Infant wide-field retinal image; 1240x1240px; acquired on the Phoenix ICON:
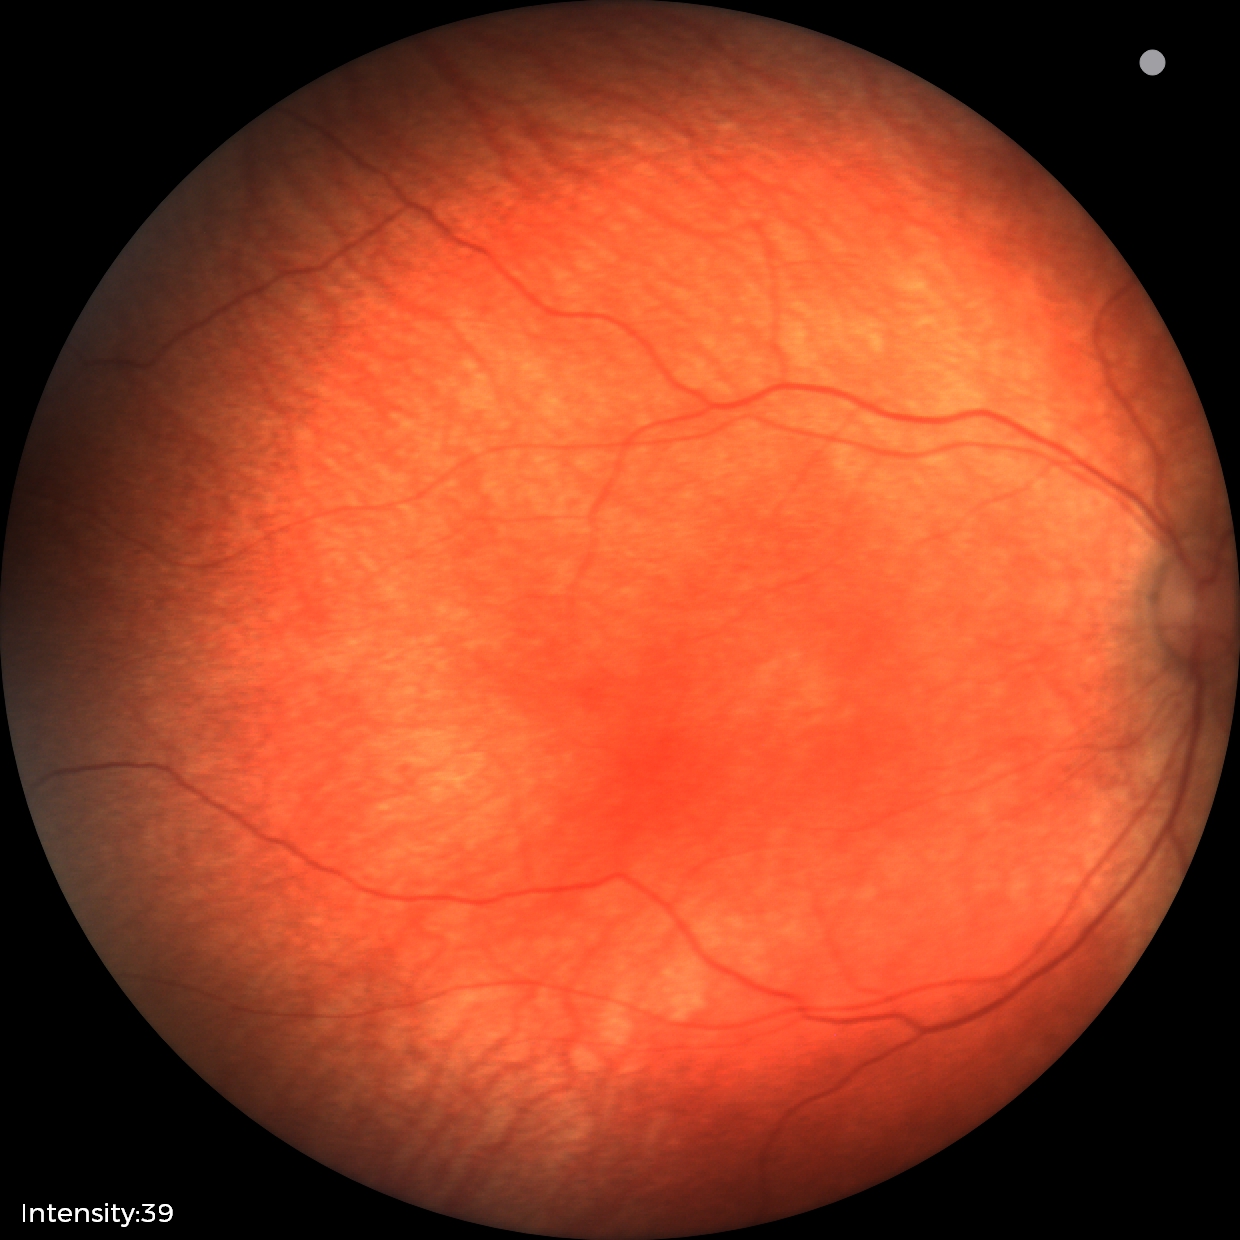

Q: What was the screening finding?
A: physiological retinal finding